Posterior pole photograph; DR severity per modified Davis staging — 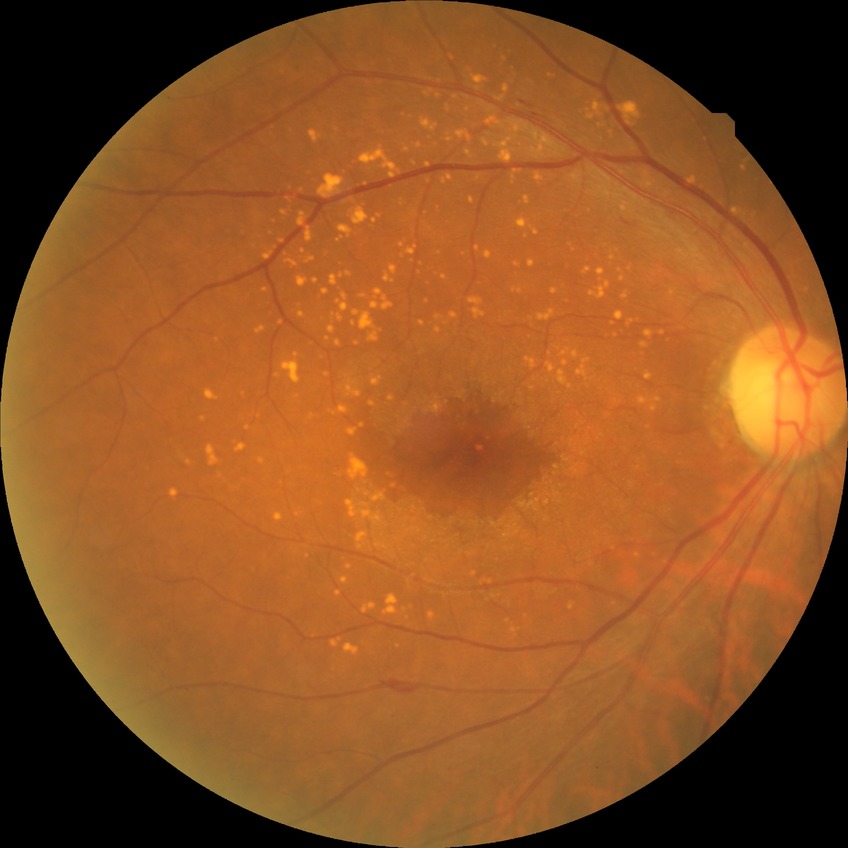
Diabetic retinopathy (DR) is no diabetic retinopathy (NDR).